Pediatric retinal photograph (wide-field)
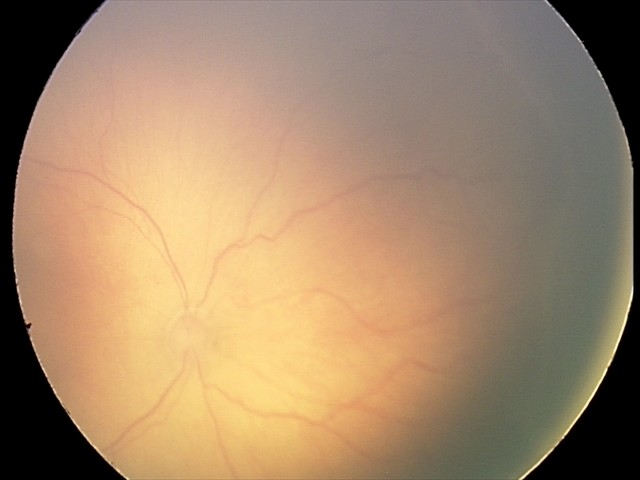 Screening diagnosis: no plus disease; ROP stage 2 — ridge with height and width at the demarcation line.